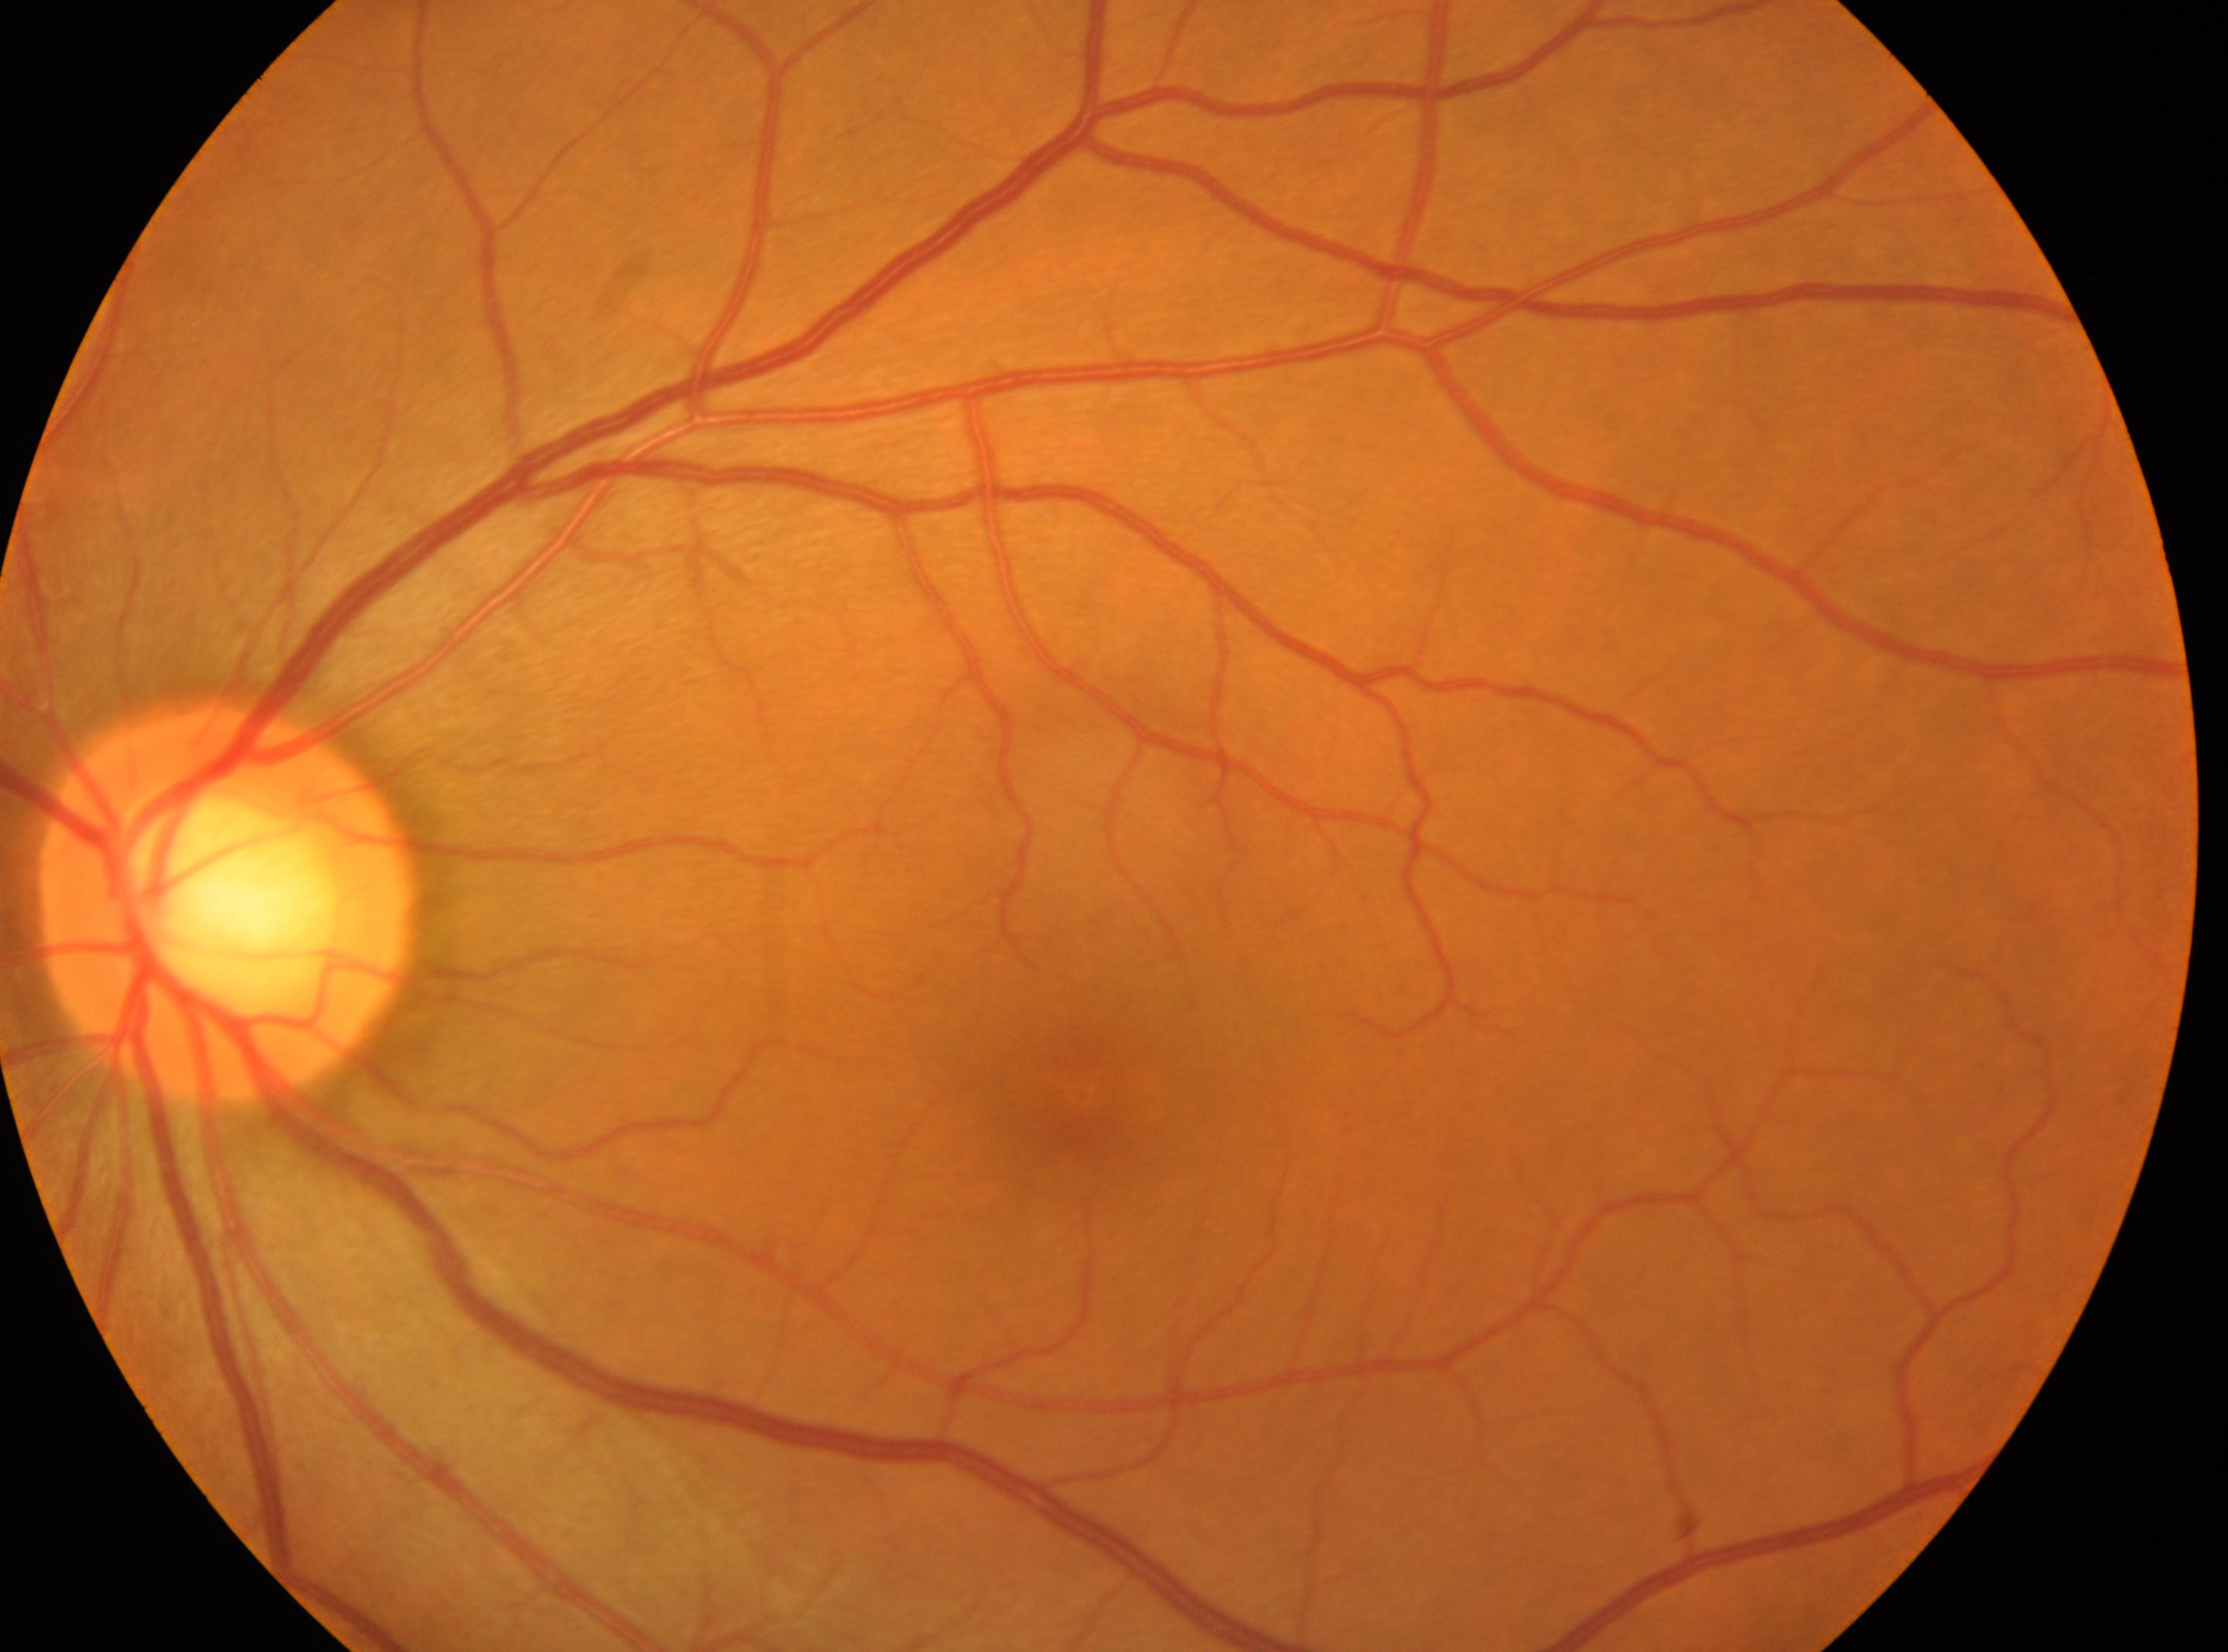
disc center: (x: 226, y: 903)
diabetic retinopathy (DR): 0/4
laterality: oculus sinister
DR impression: No signs of diabetic retinopathy
fovea centralis: (x: 1078, y: 1092)